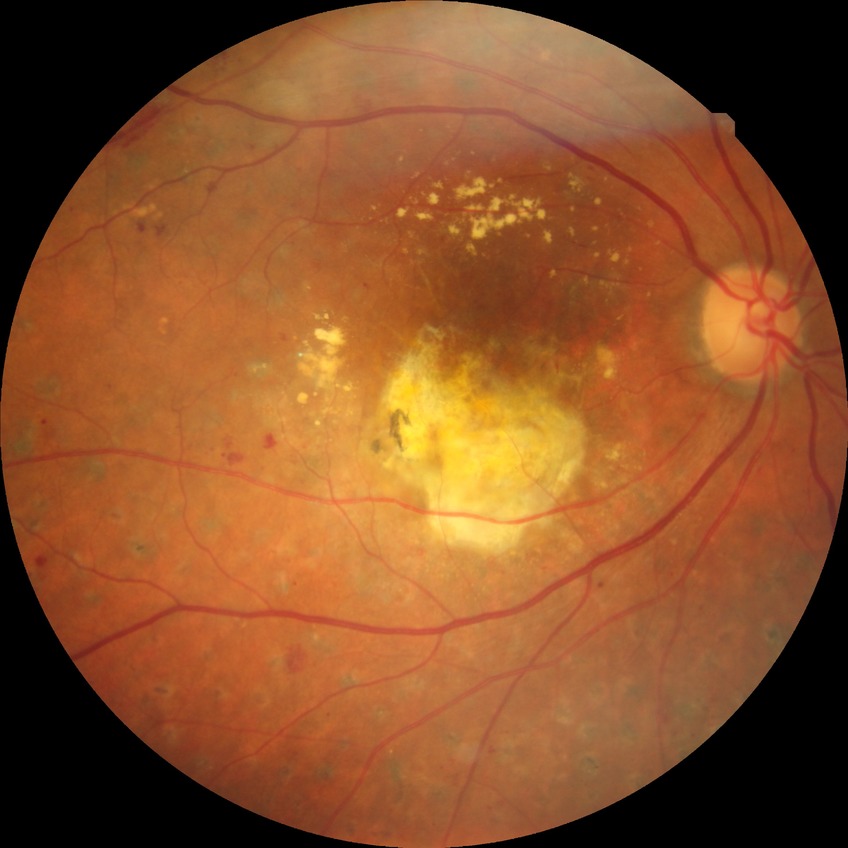 davis_grade: PDR (proliferative diabetic retinopathy)